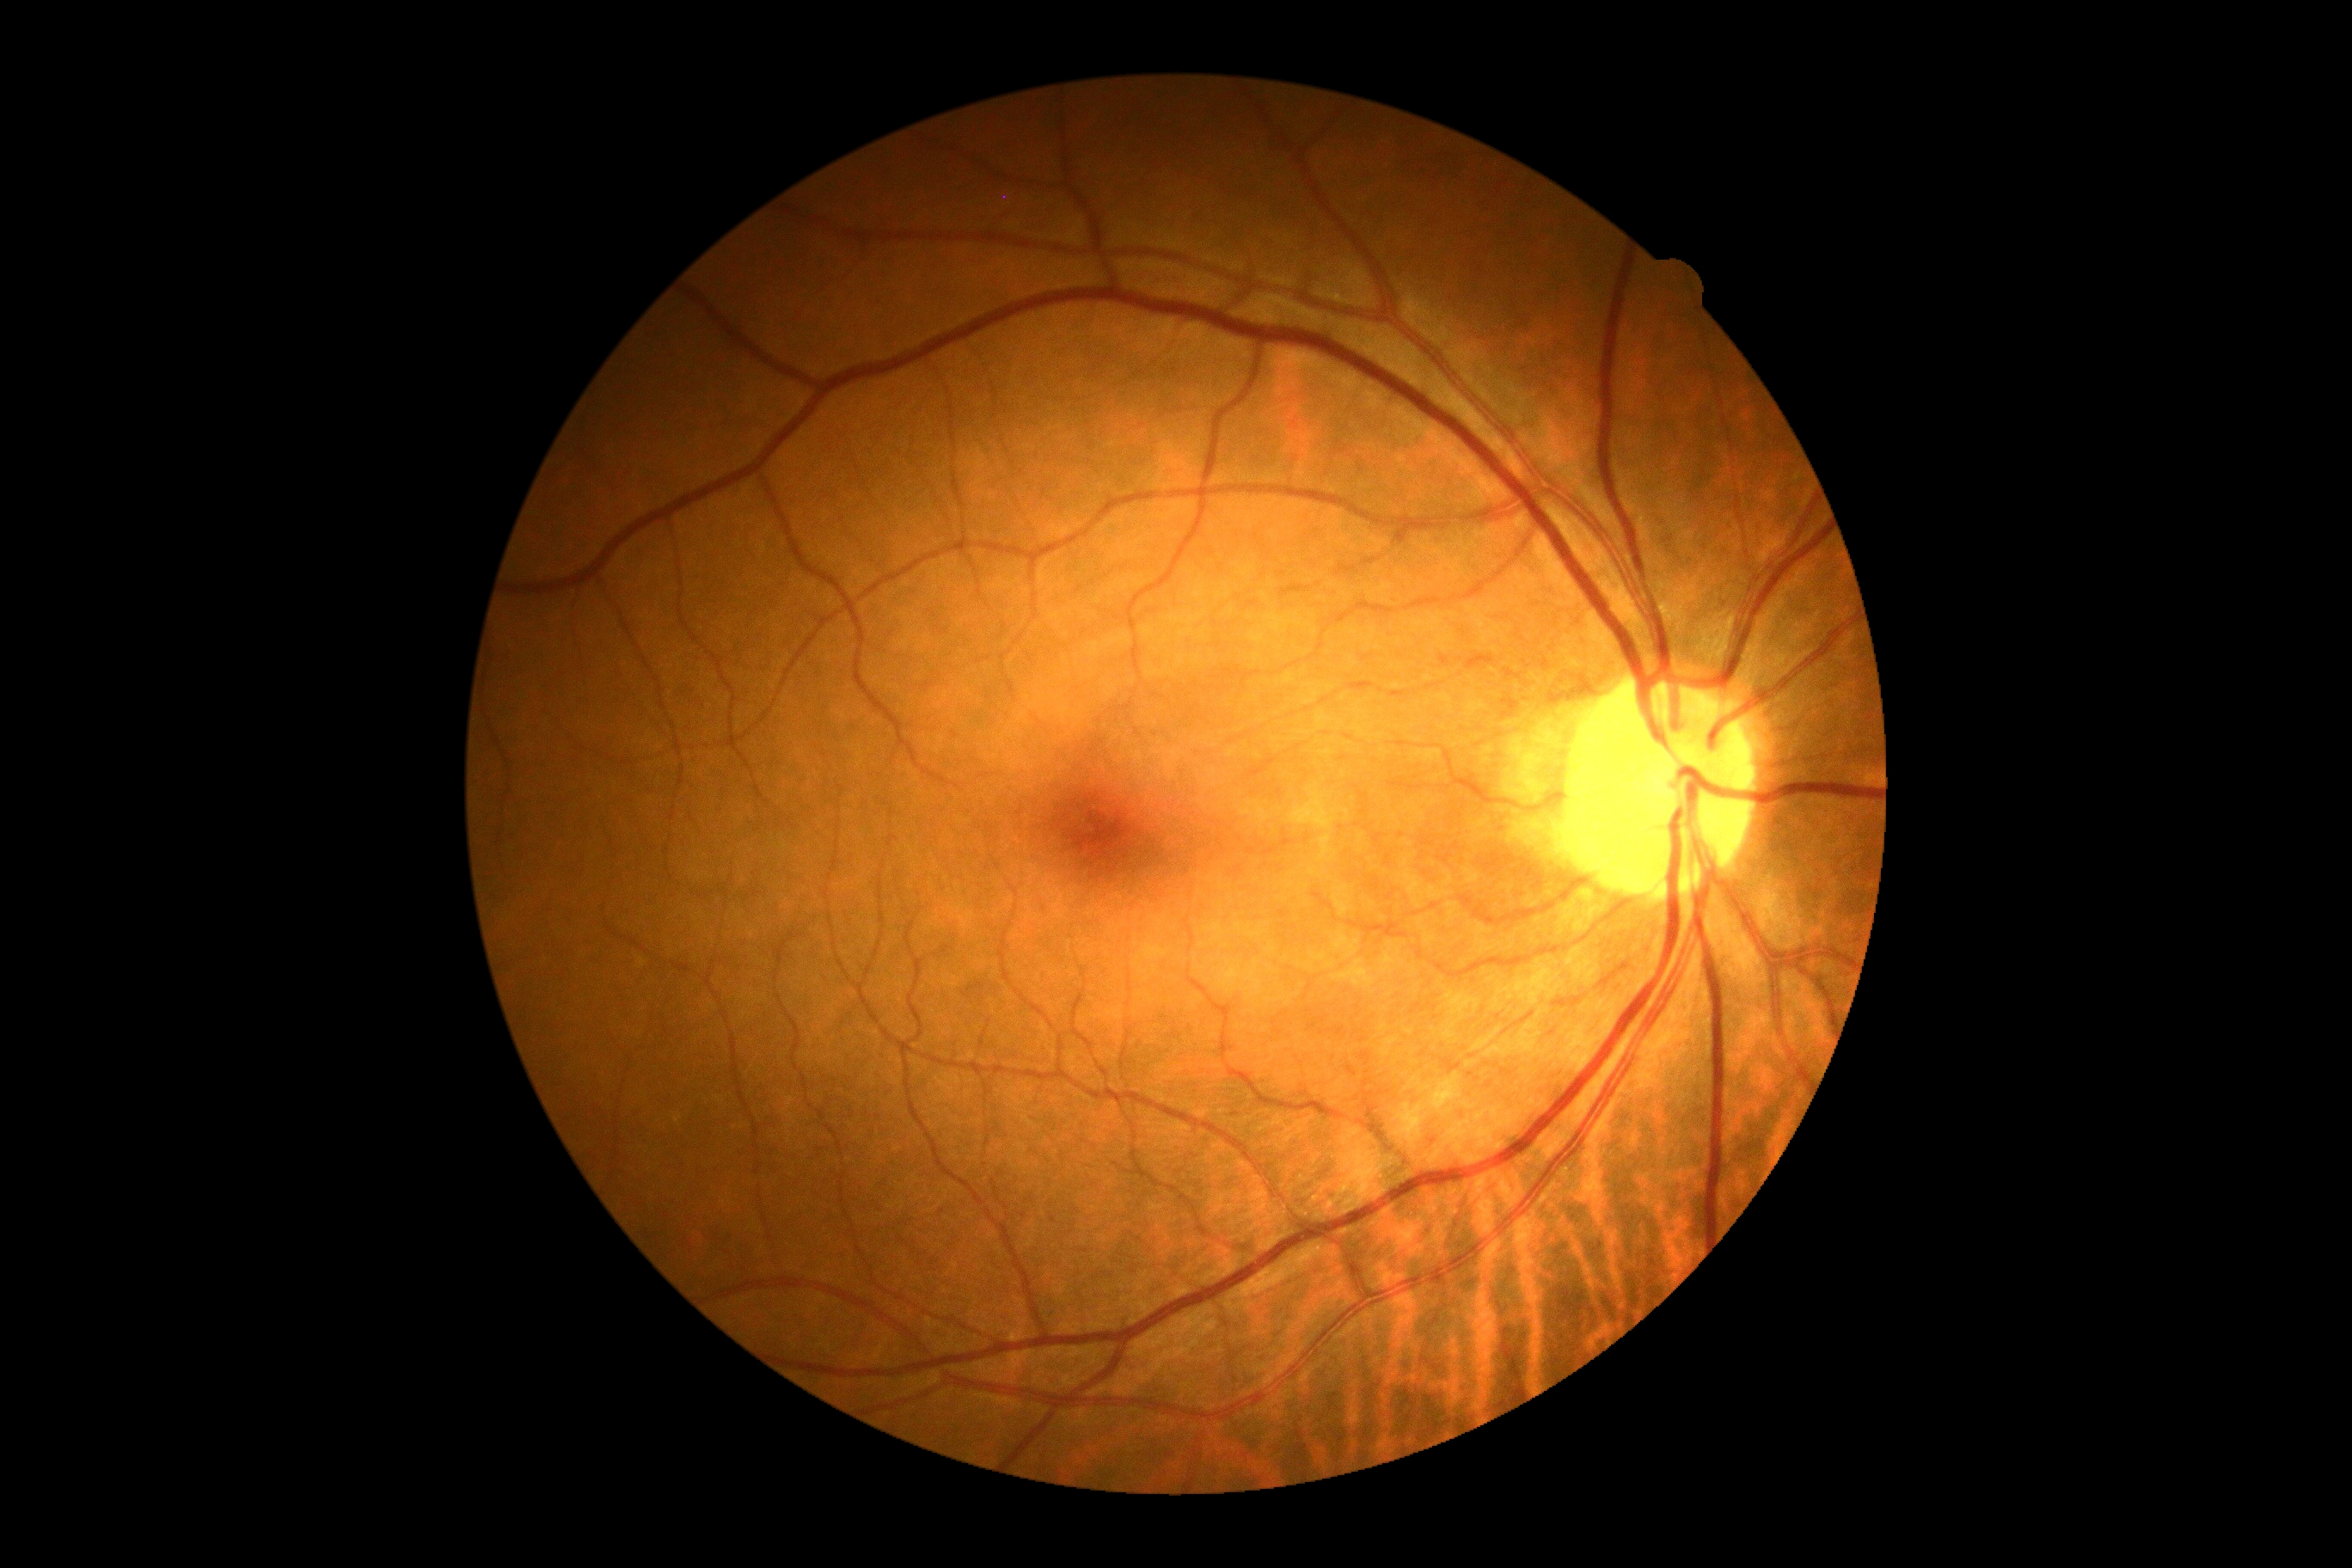 Retinopathy: no apparent retinopathy (grade 0). No DR findings.